Nonmydriatic · 848x848px.
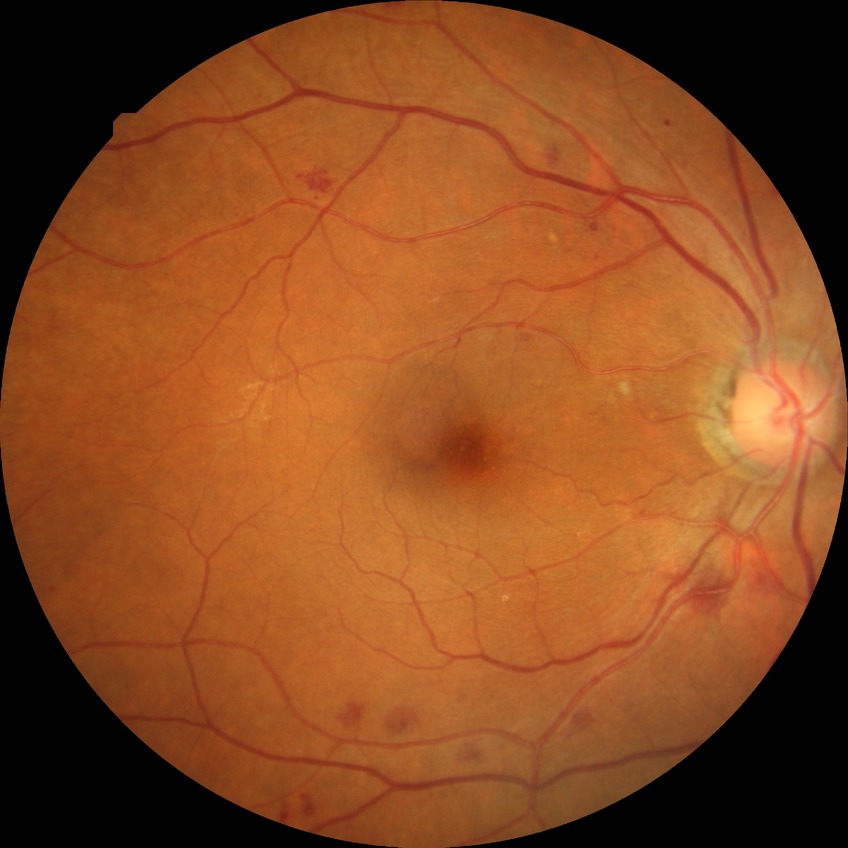
Davis grade: SDR.